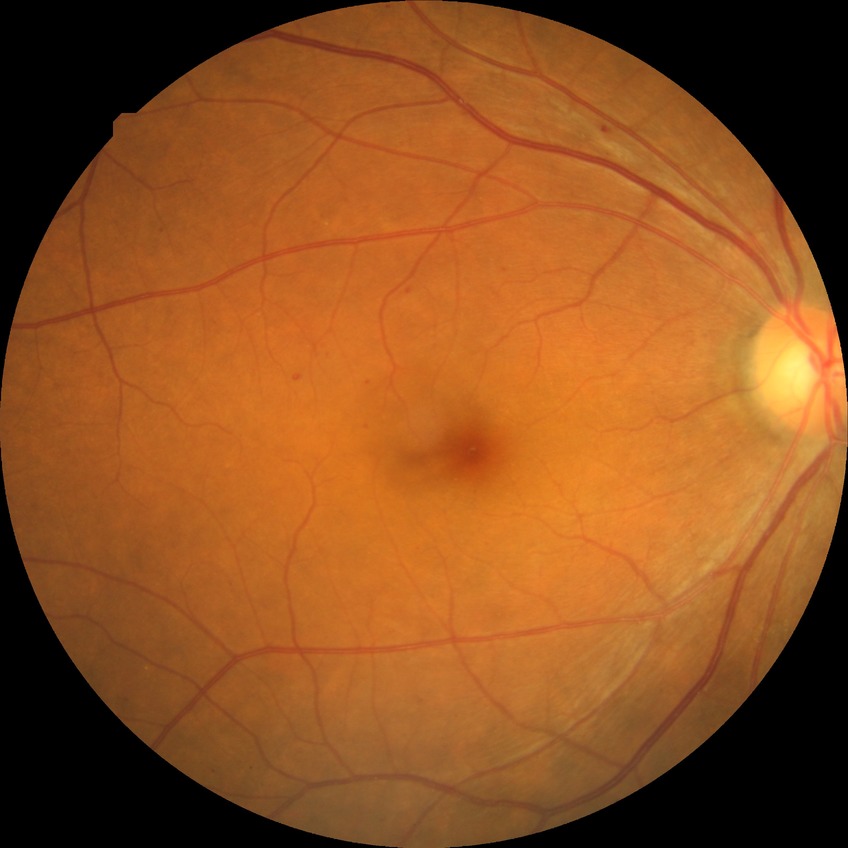

DR class = non-proliferative diabetic retinopathy, diabetic retinopathy (DR) = SDR (simple diabetic retinopathy).